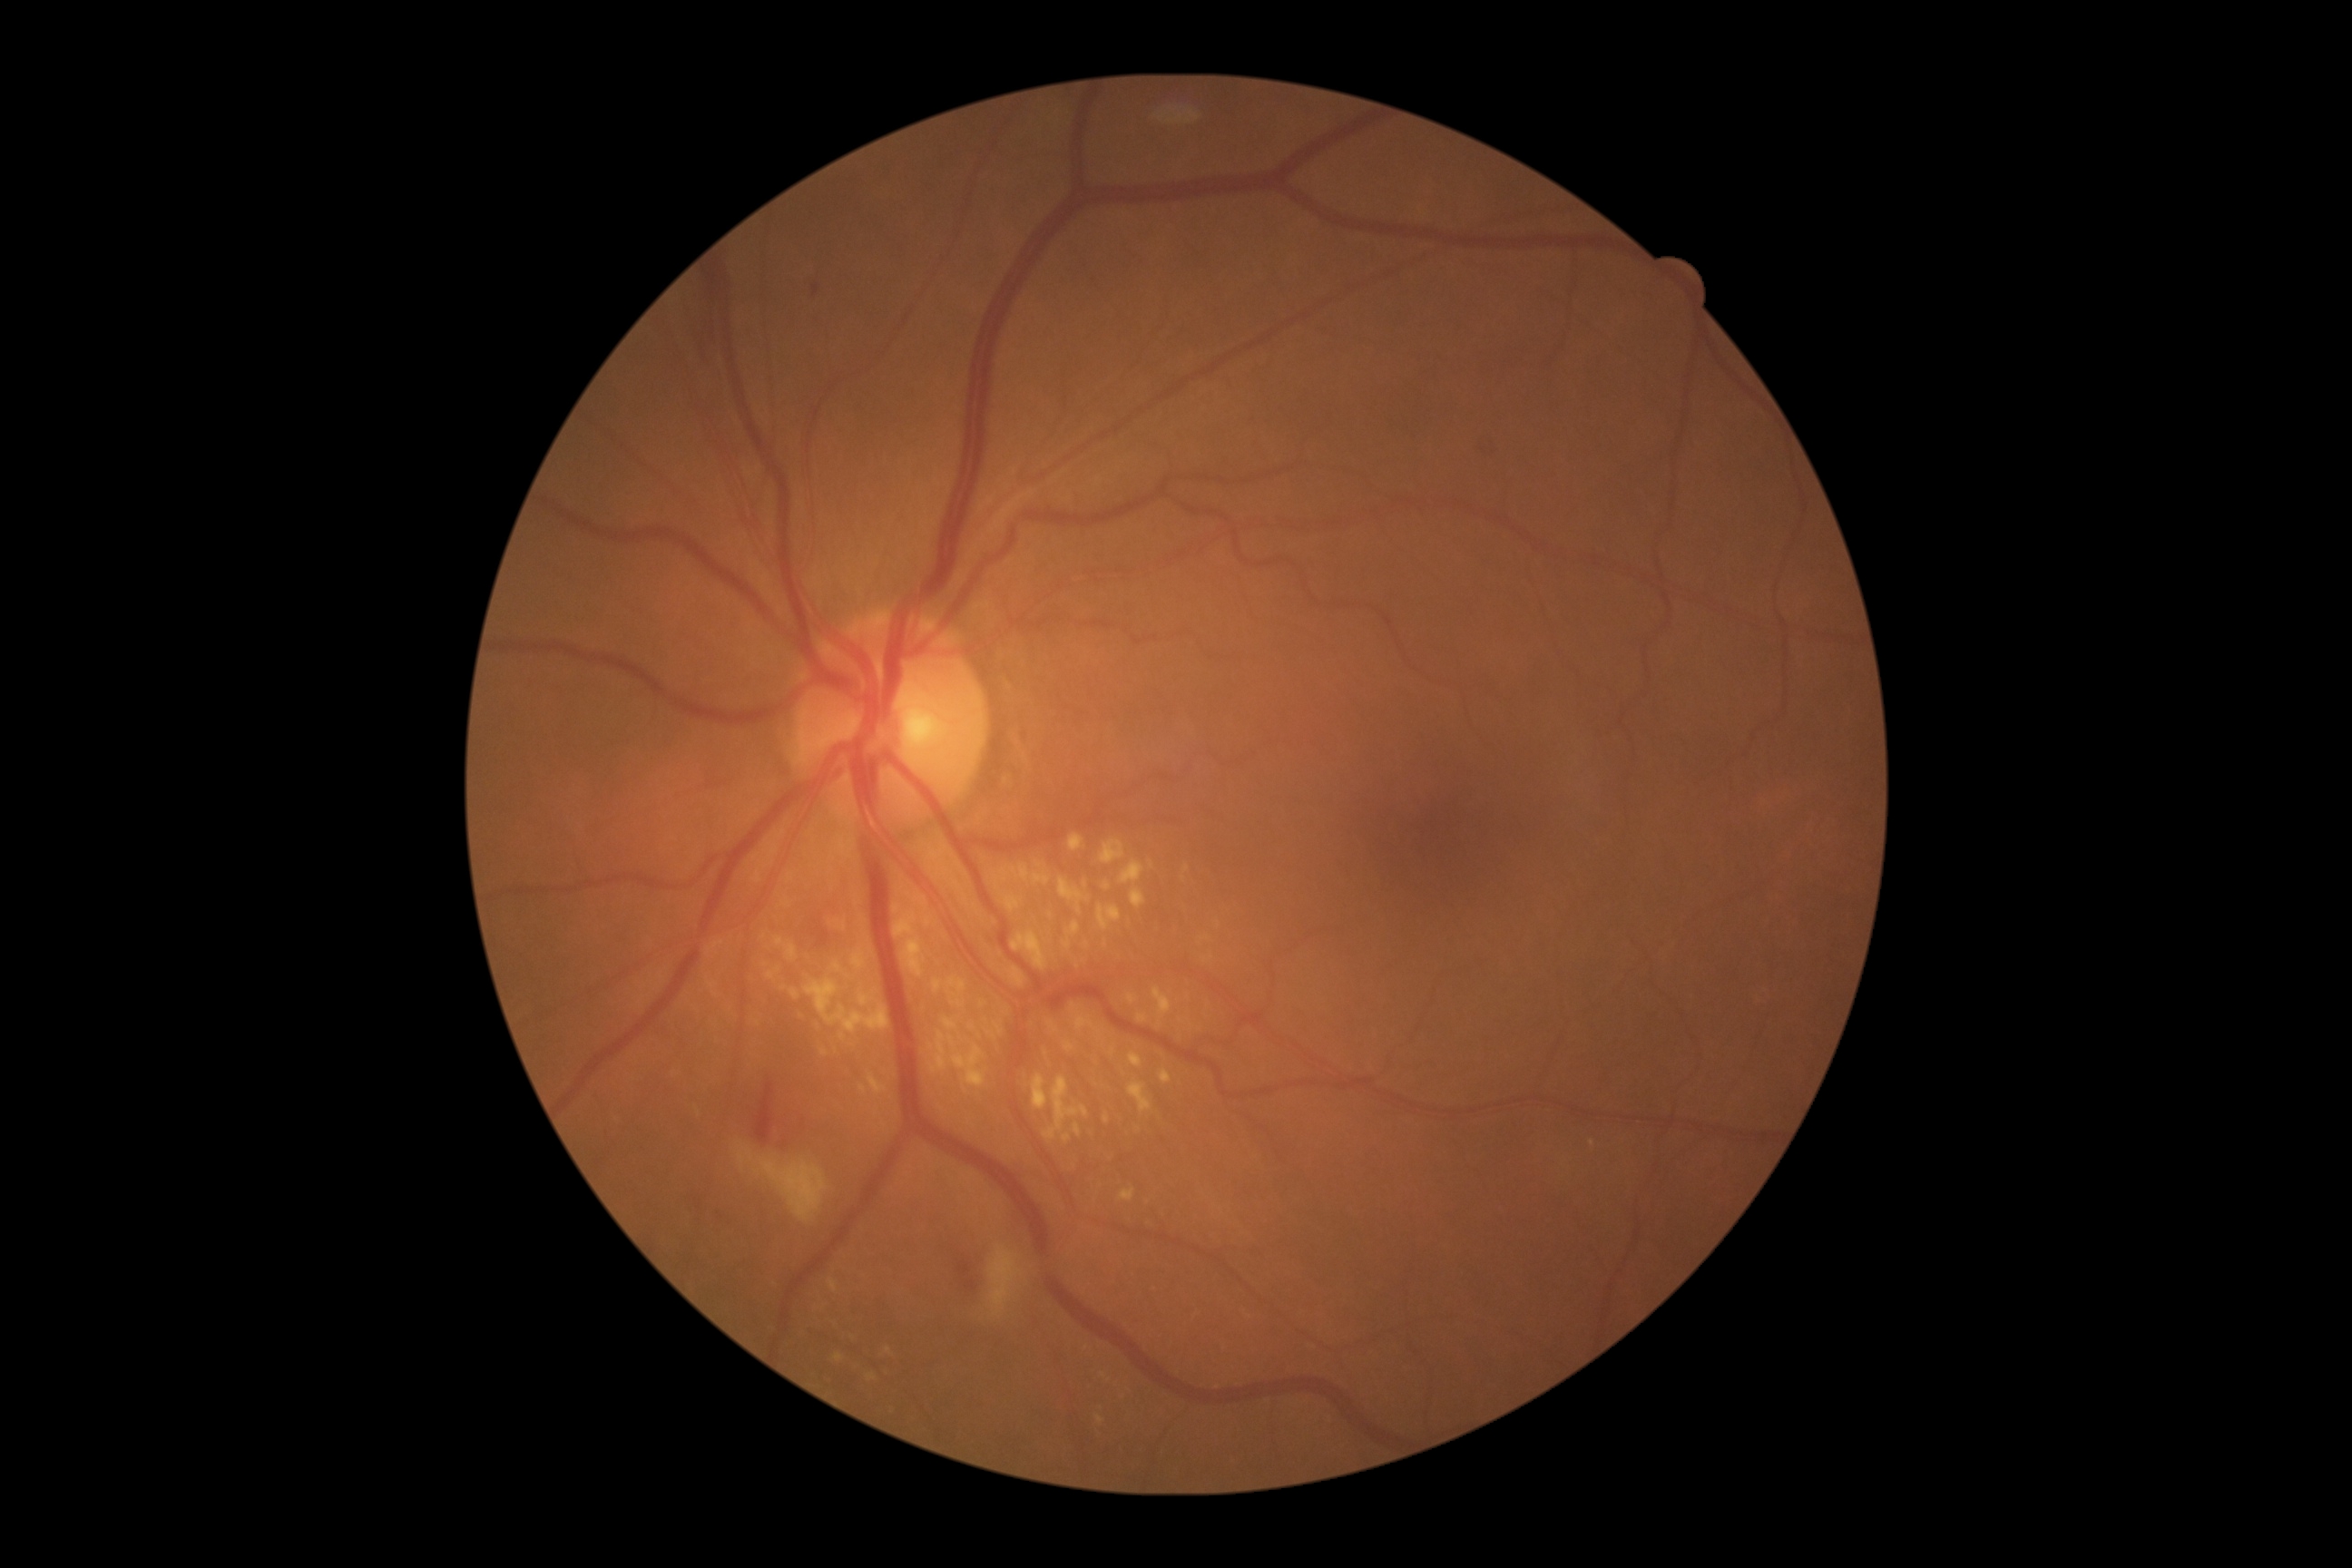 – DR severity: grade 2